Nonmydriatic · 848x848: 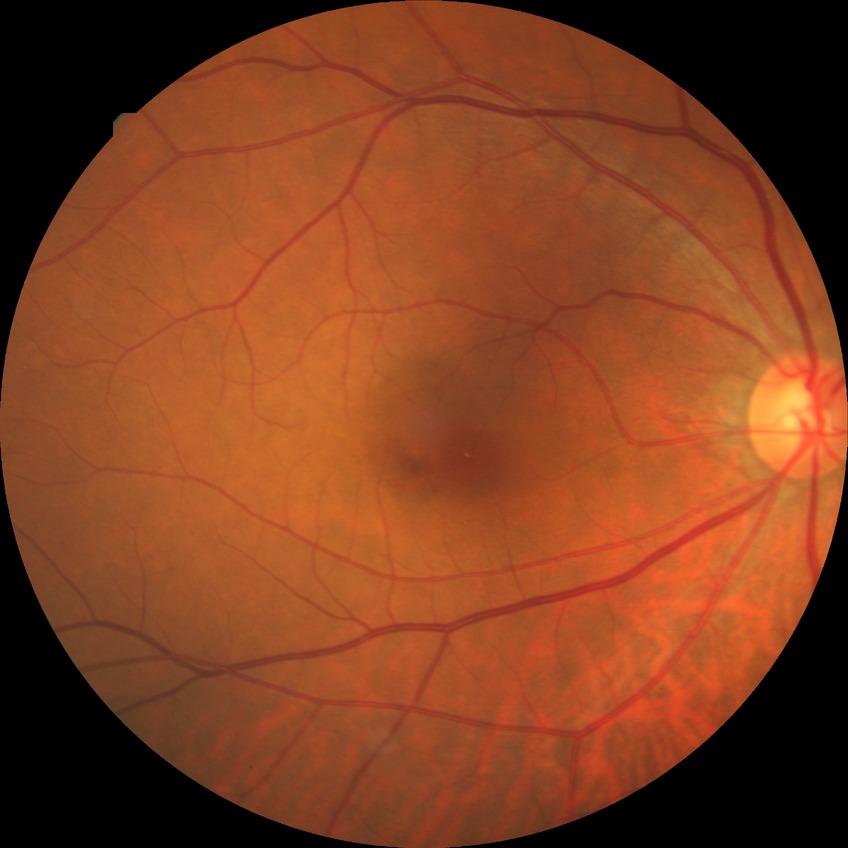 Diabetic retinopathy (DR) is no diabetic retinopathy (NDR).